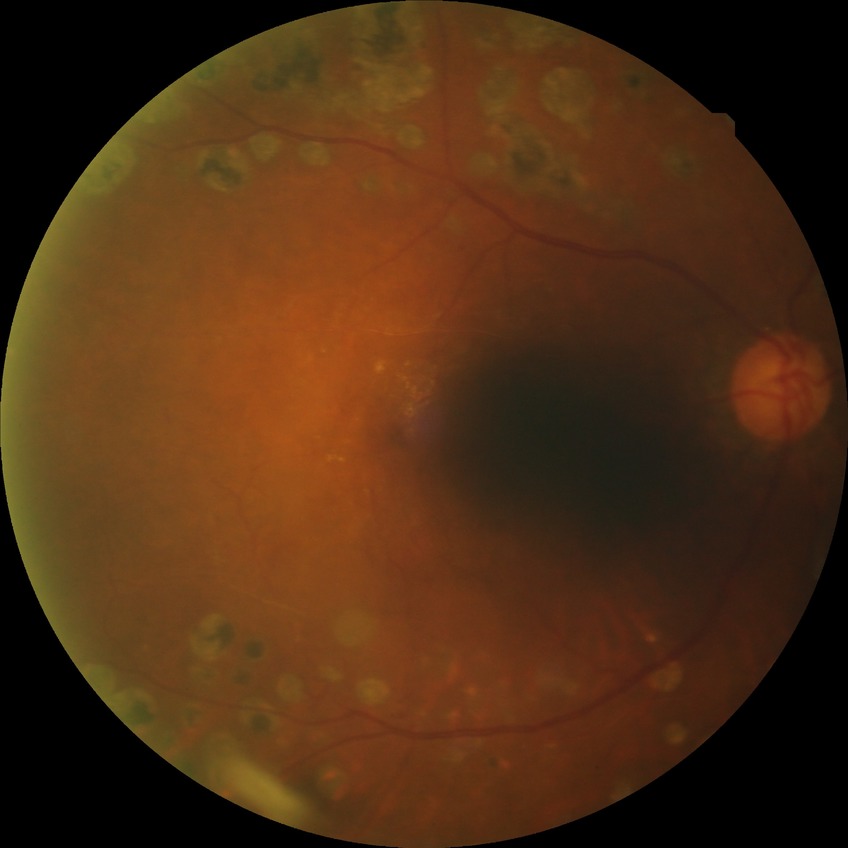

Annotations:
– diabetic retinopathy stage: proliferative diabetic retinopathy